2102x1736px — 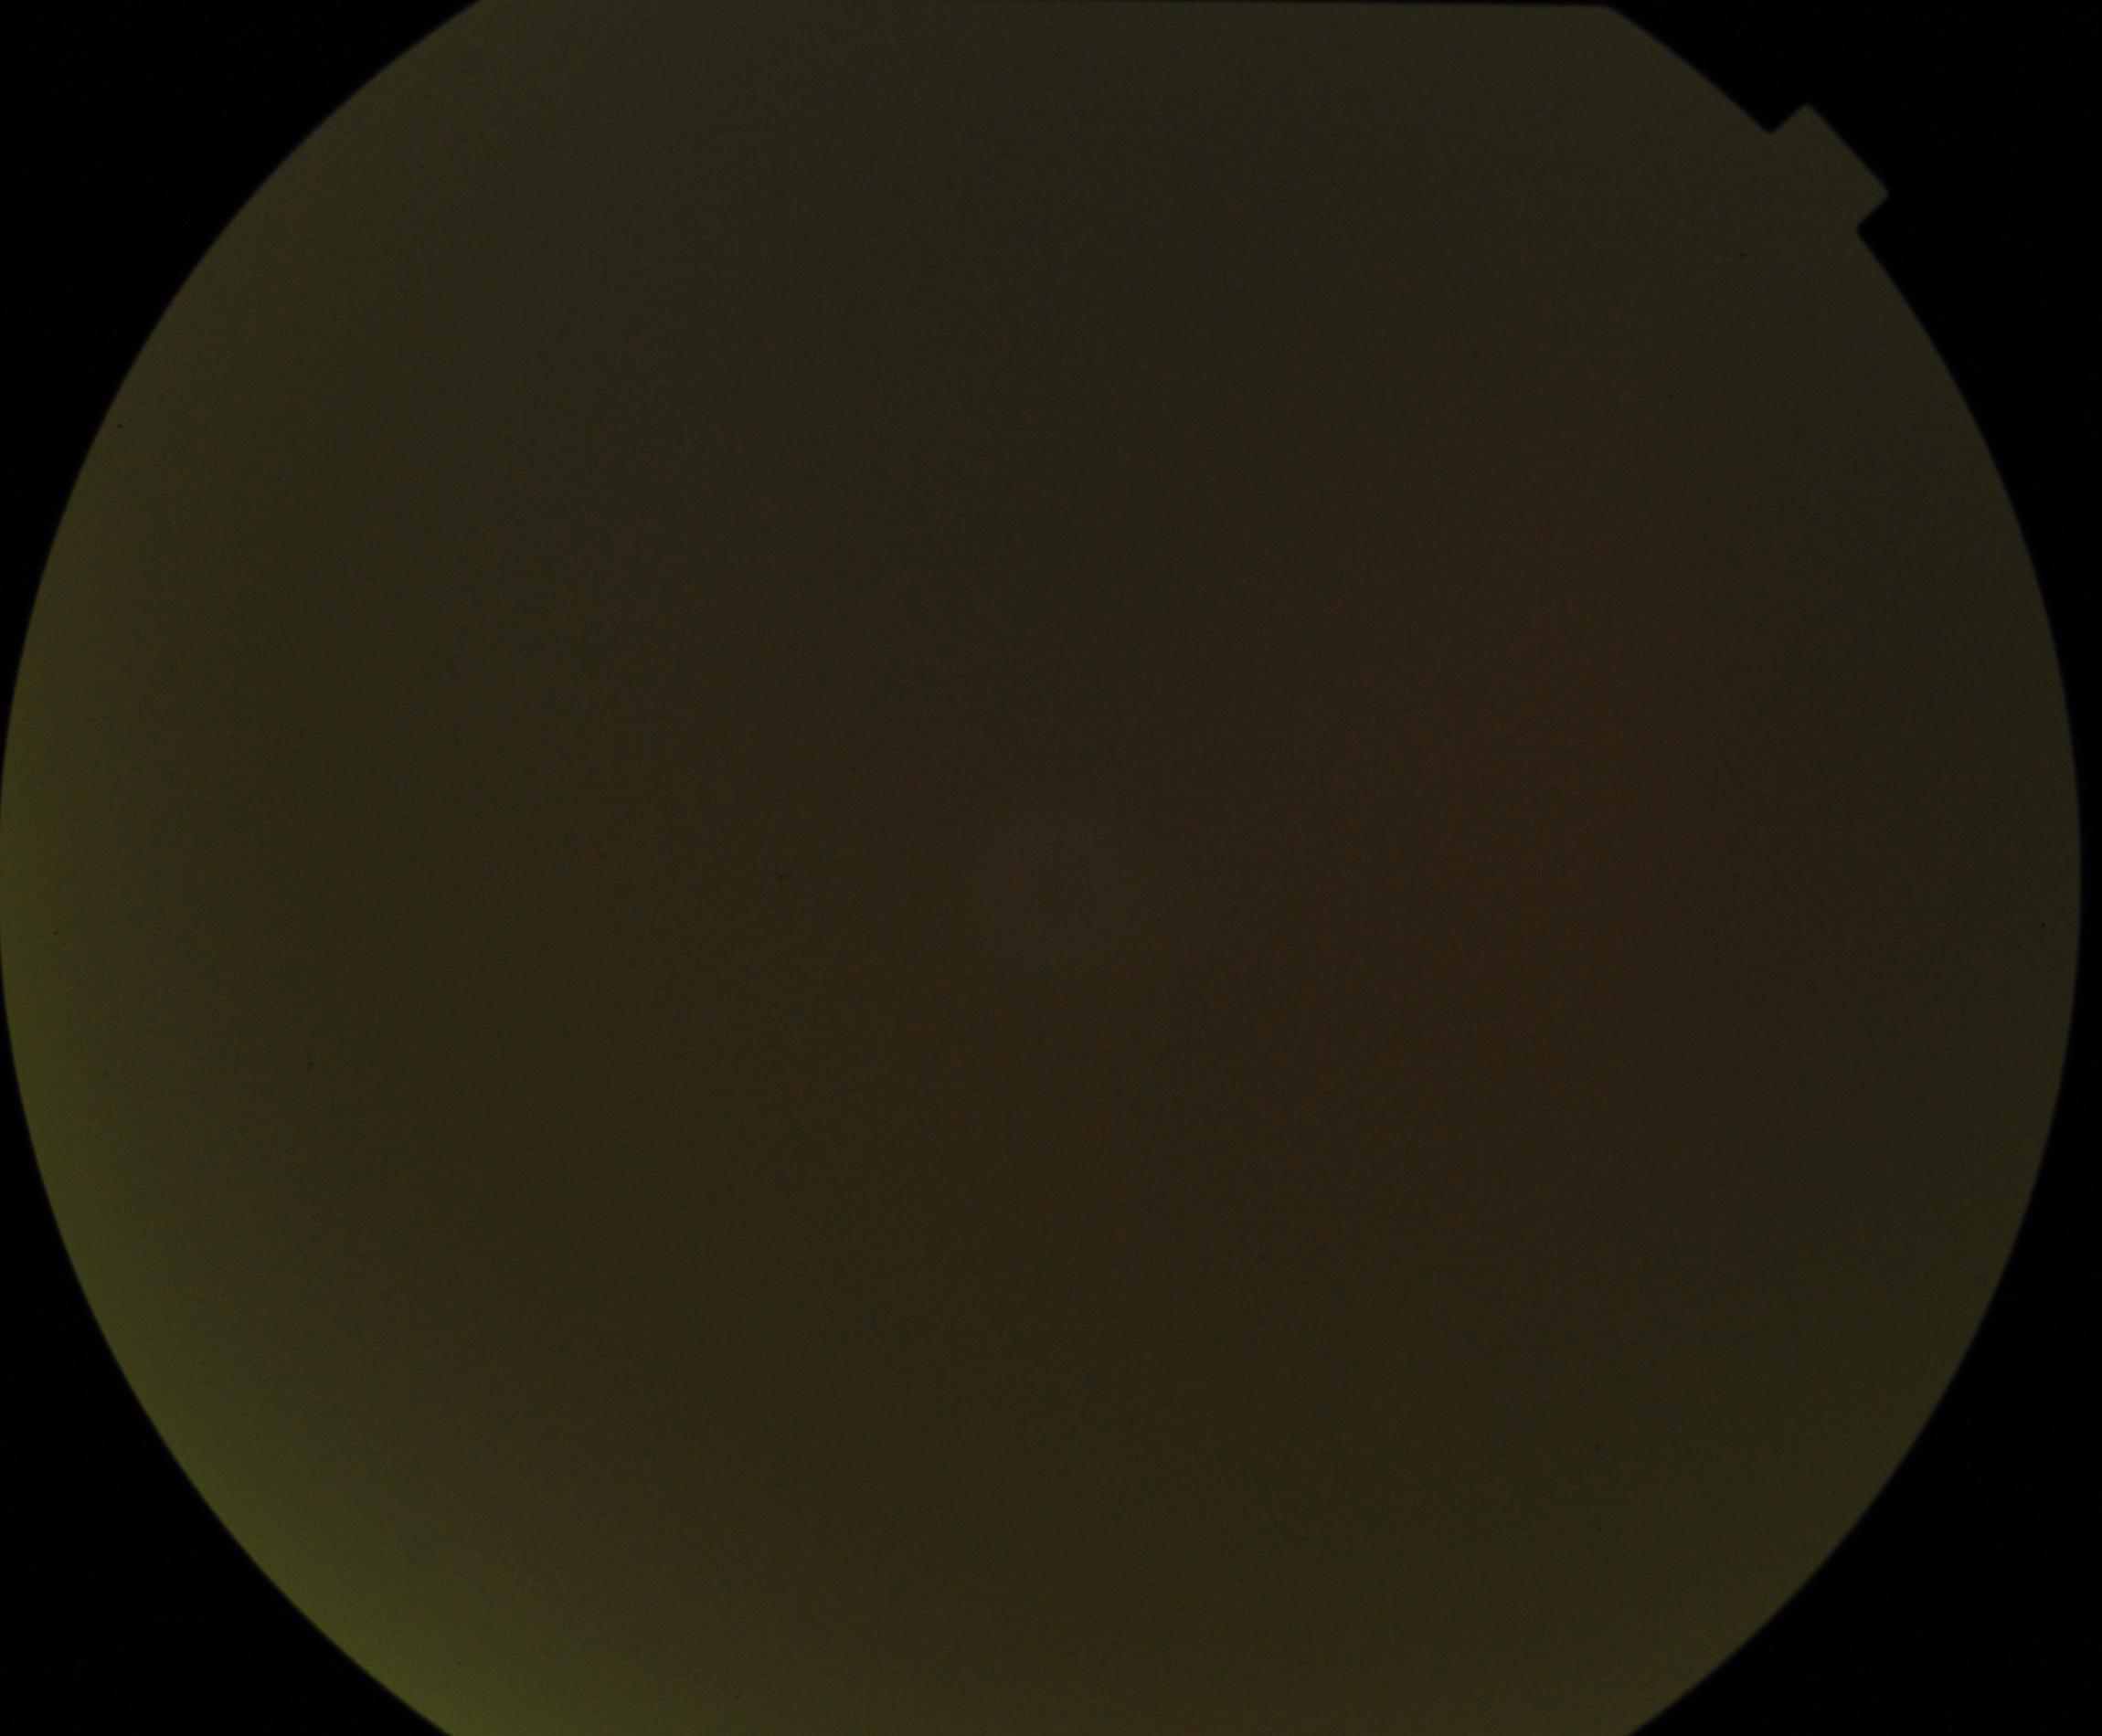 Image is blurred; retinal landmarks are largely obscured. No proliferative diabetic retinopathy identified.